Davis DR grading — 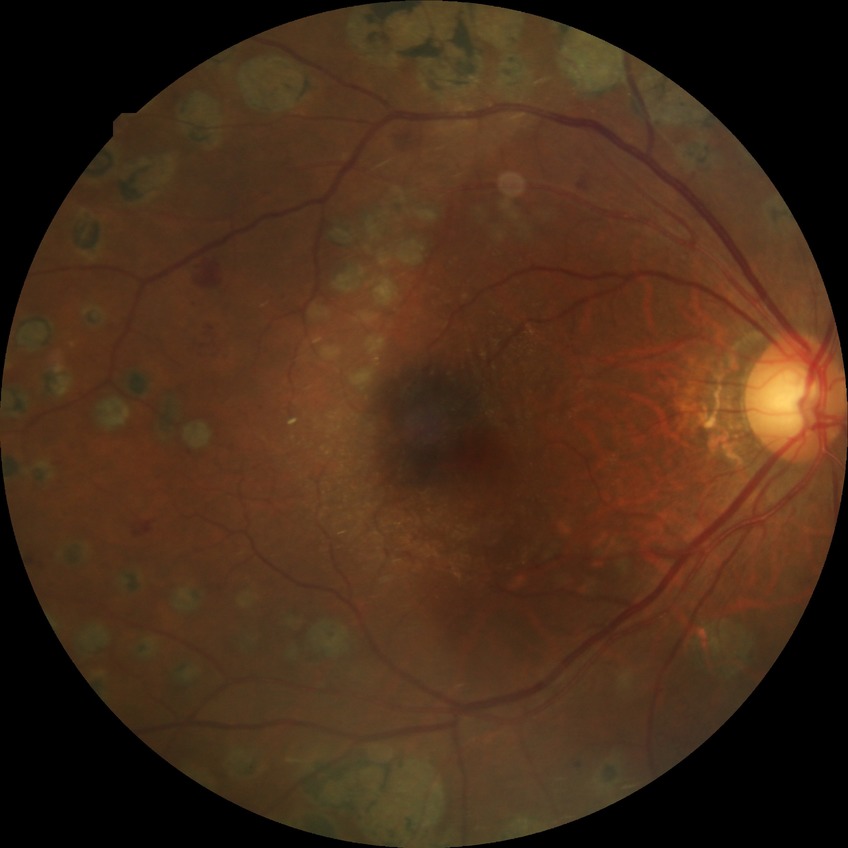
Diabetic retinopathy stage: proliferative diabetic retinopathy.